45° field of view. 2048x1536px — 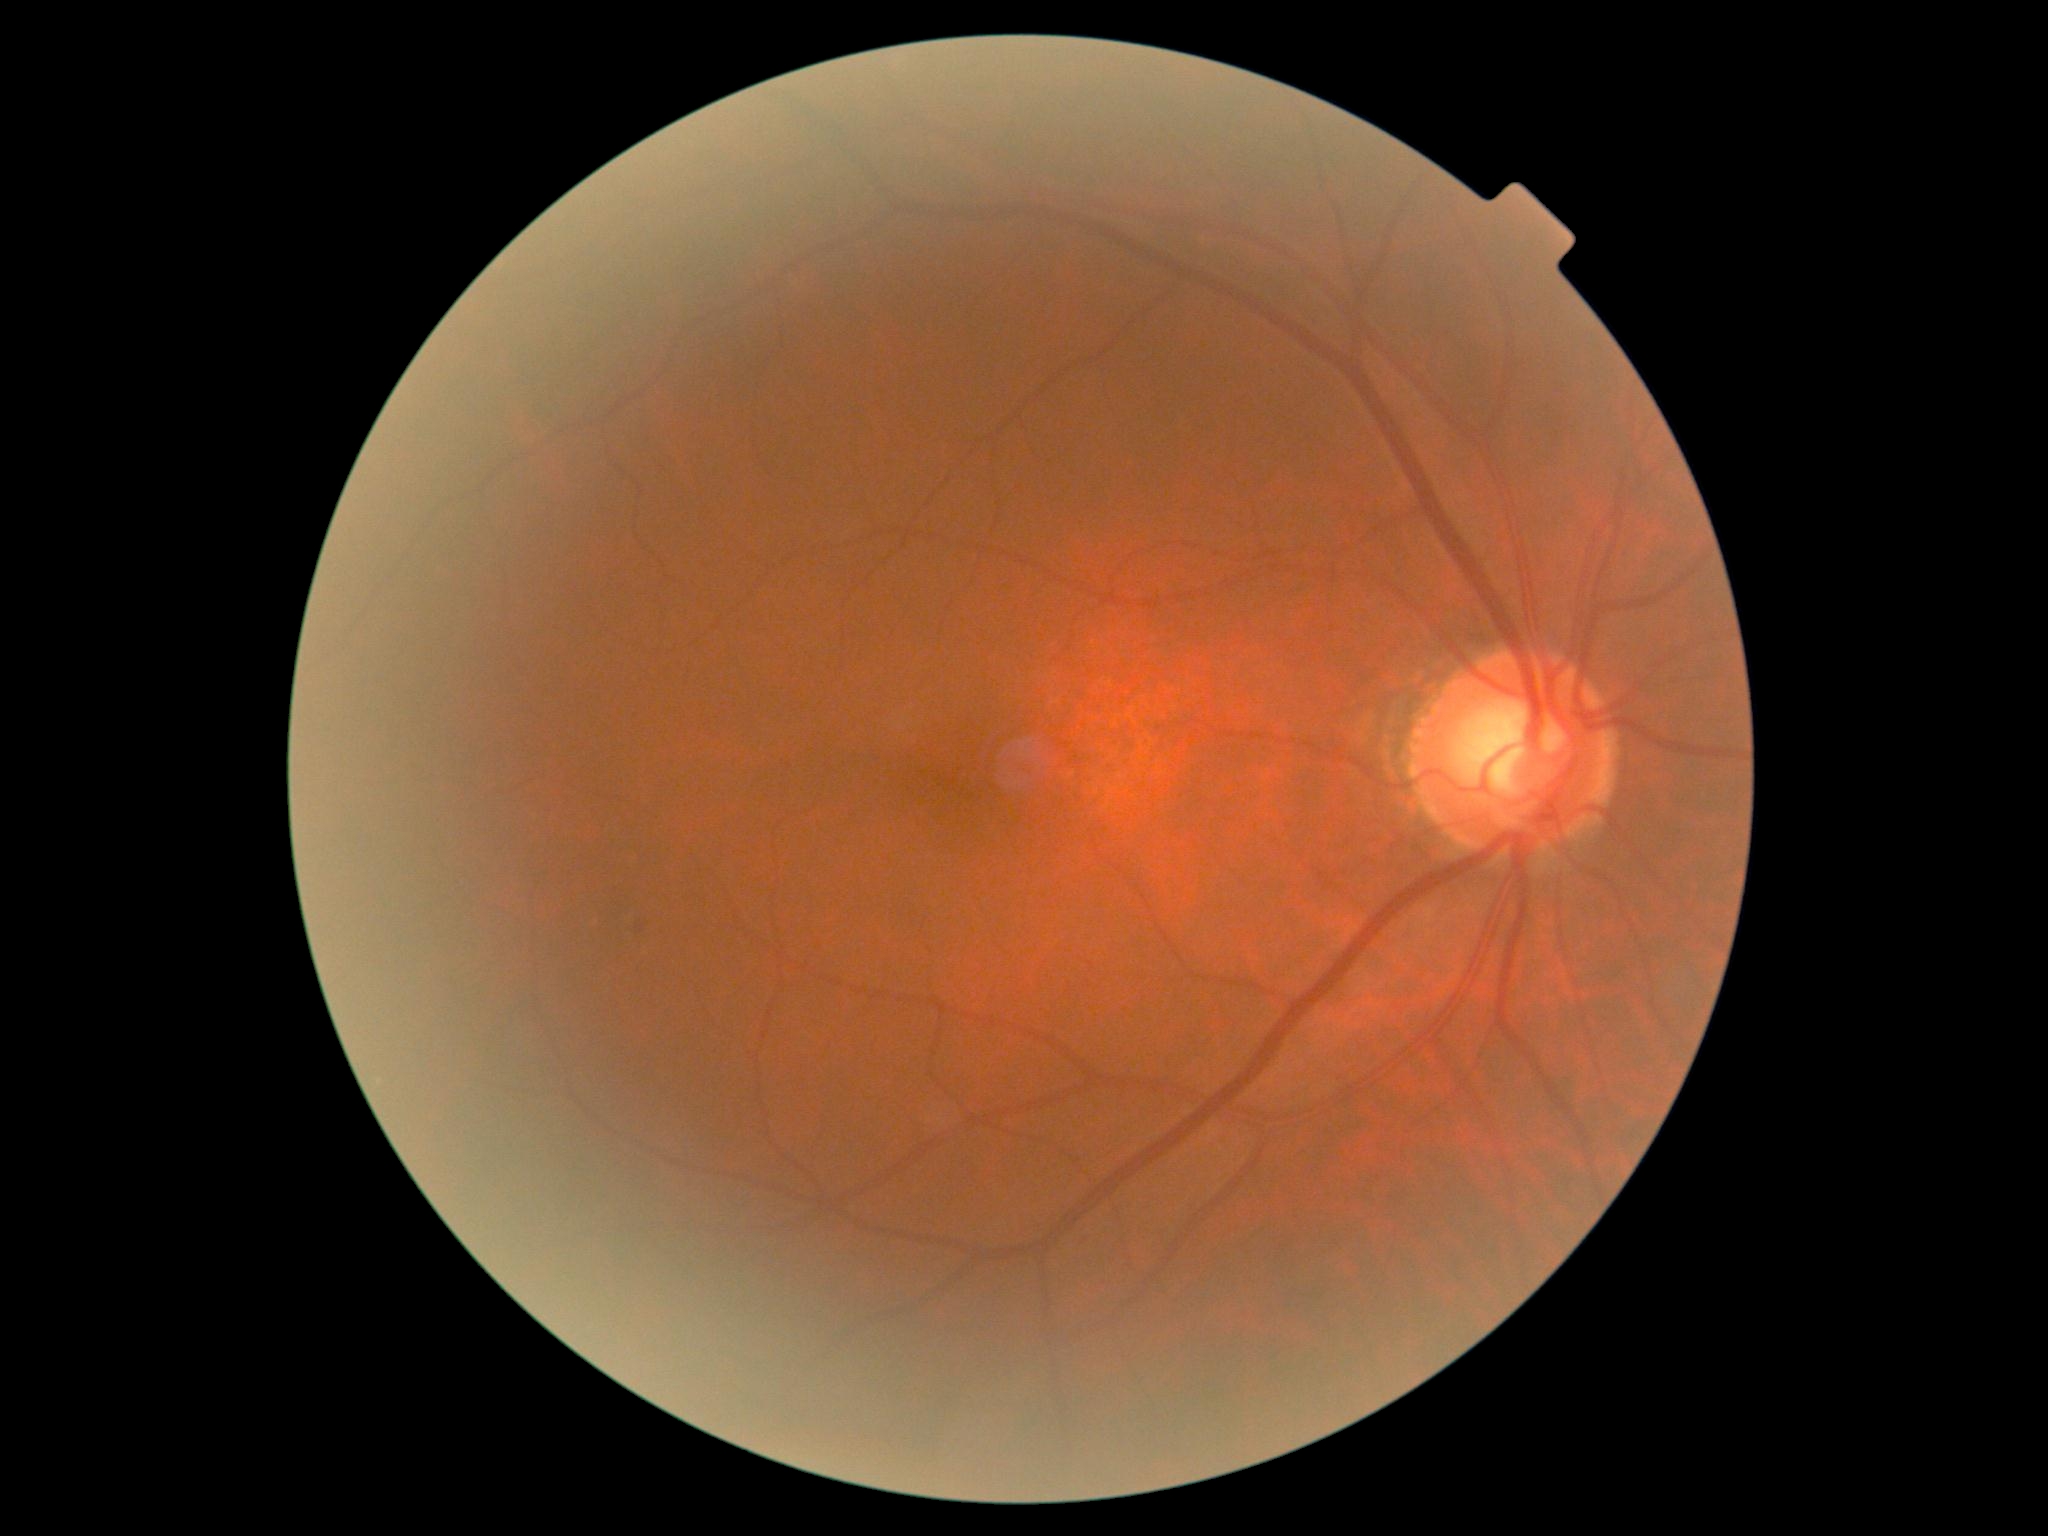 Diabetic retinopathy (DR) is grade 1.